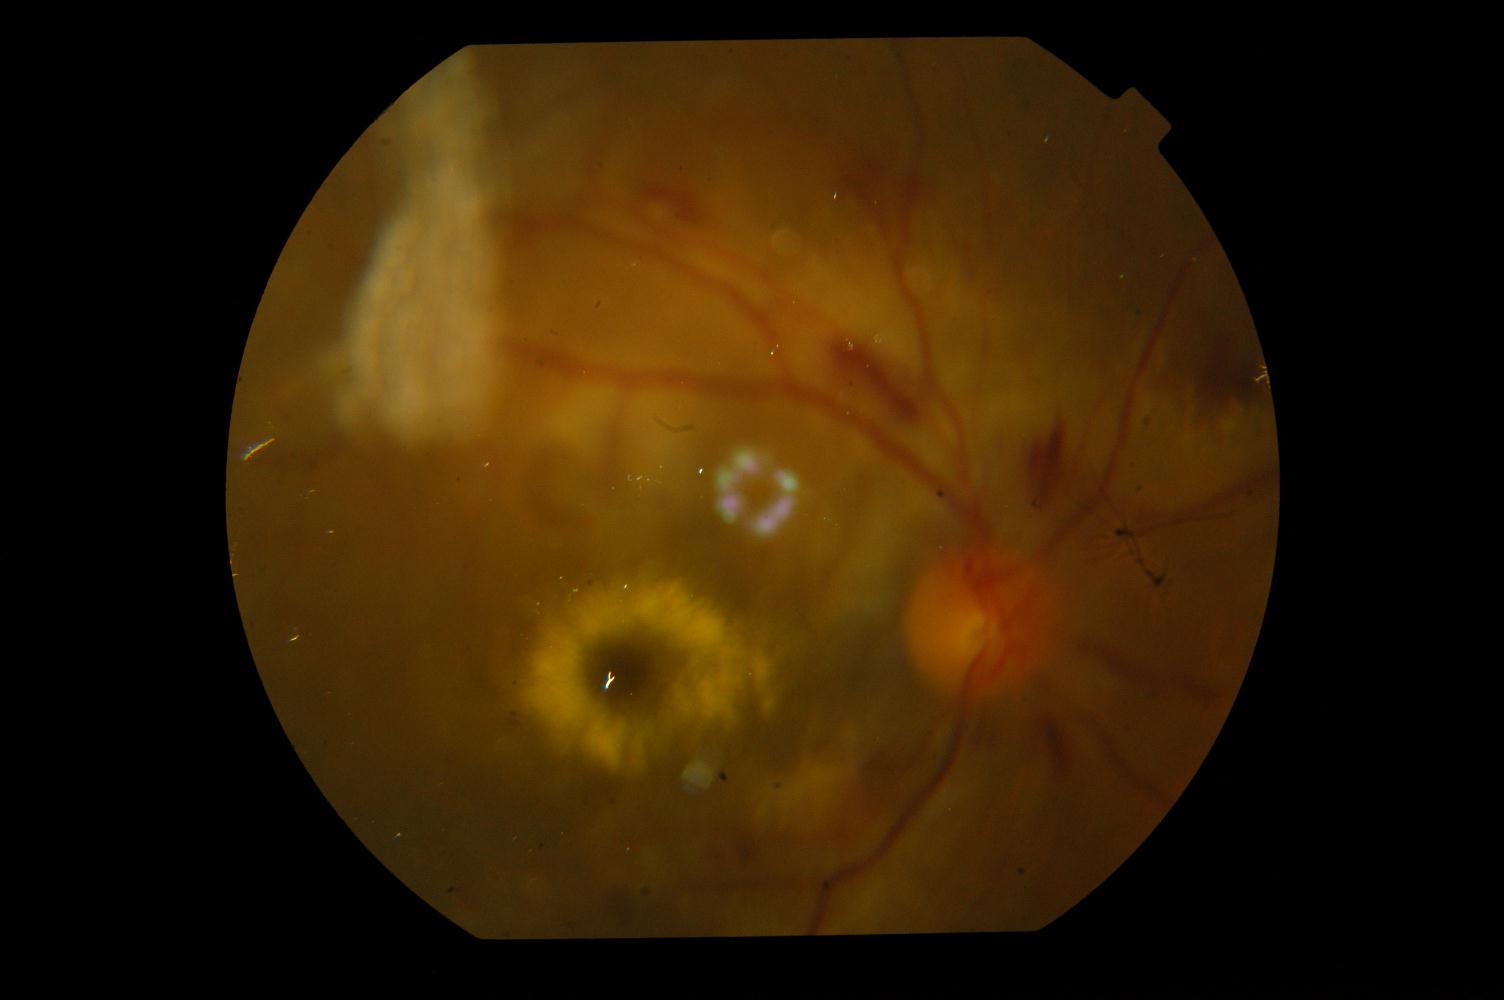
Findings consistent with hypertensive retinopathy.